Color fundus photograph — 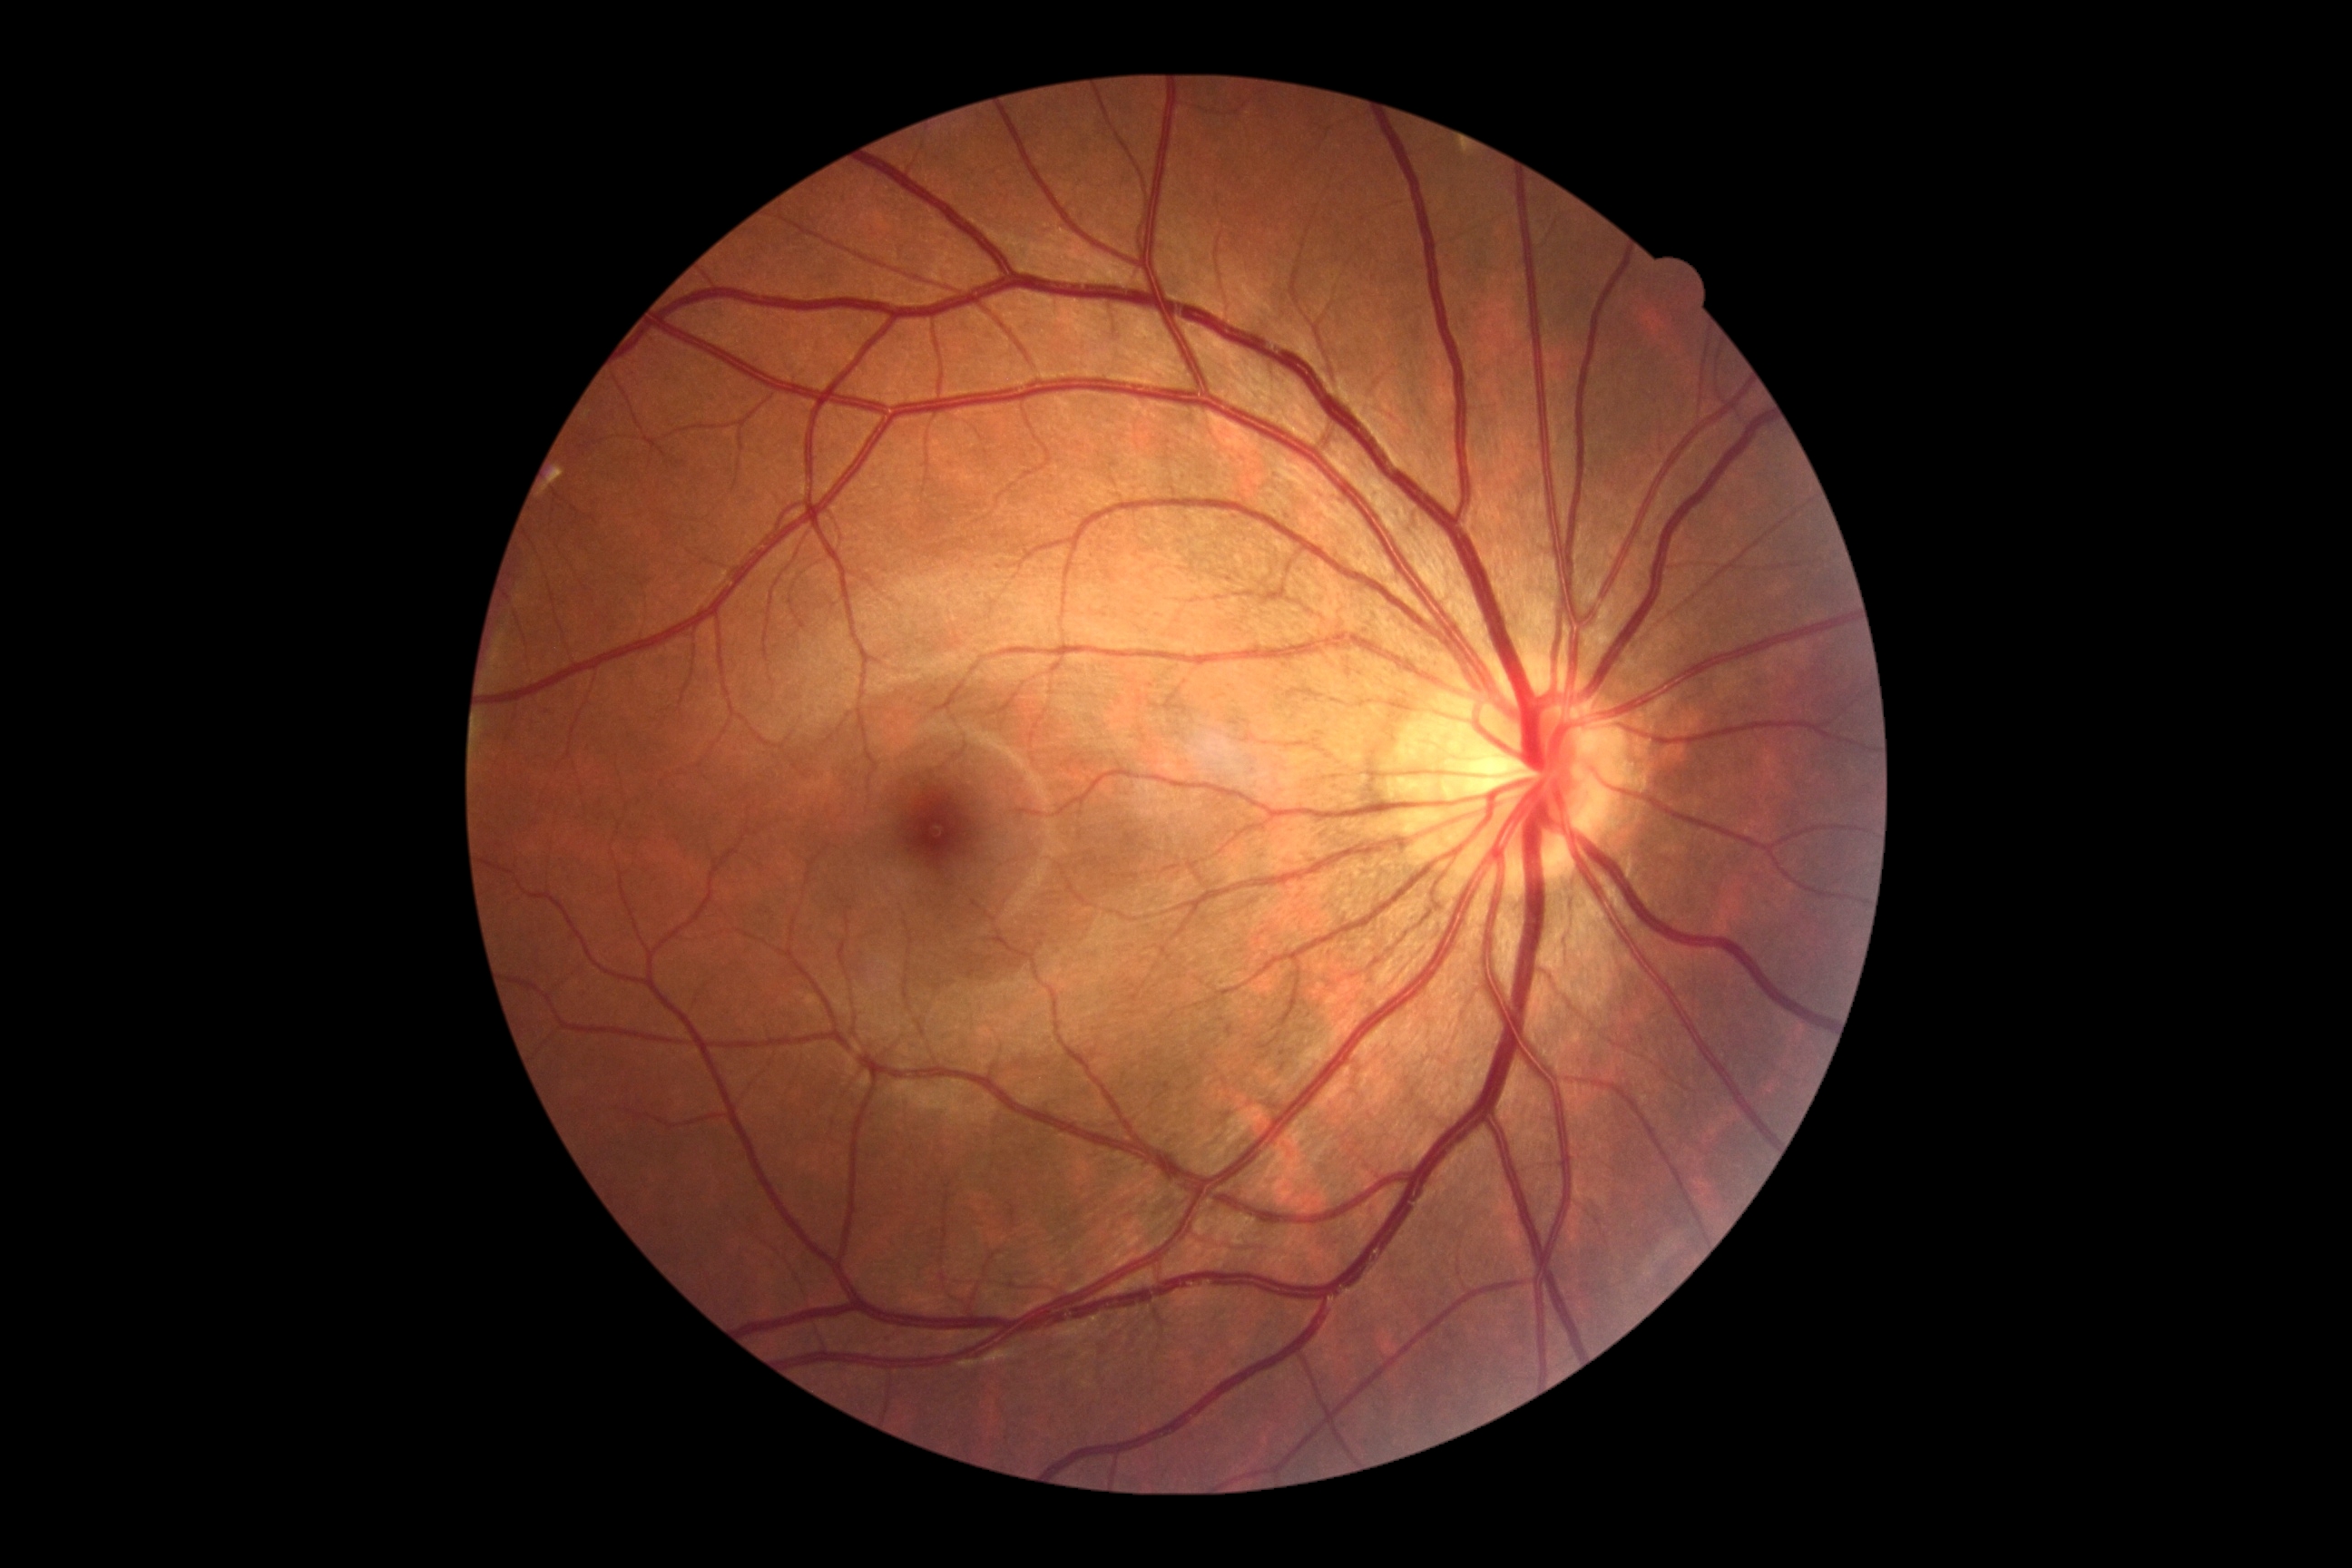

Retinopathy grade: no apparent diabetic retinopathy (0).